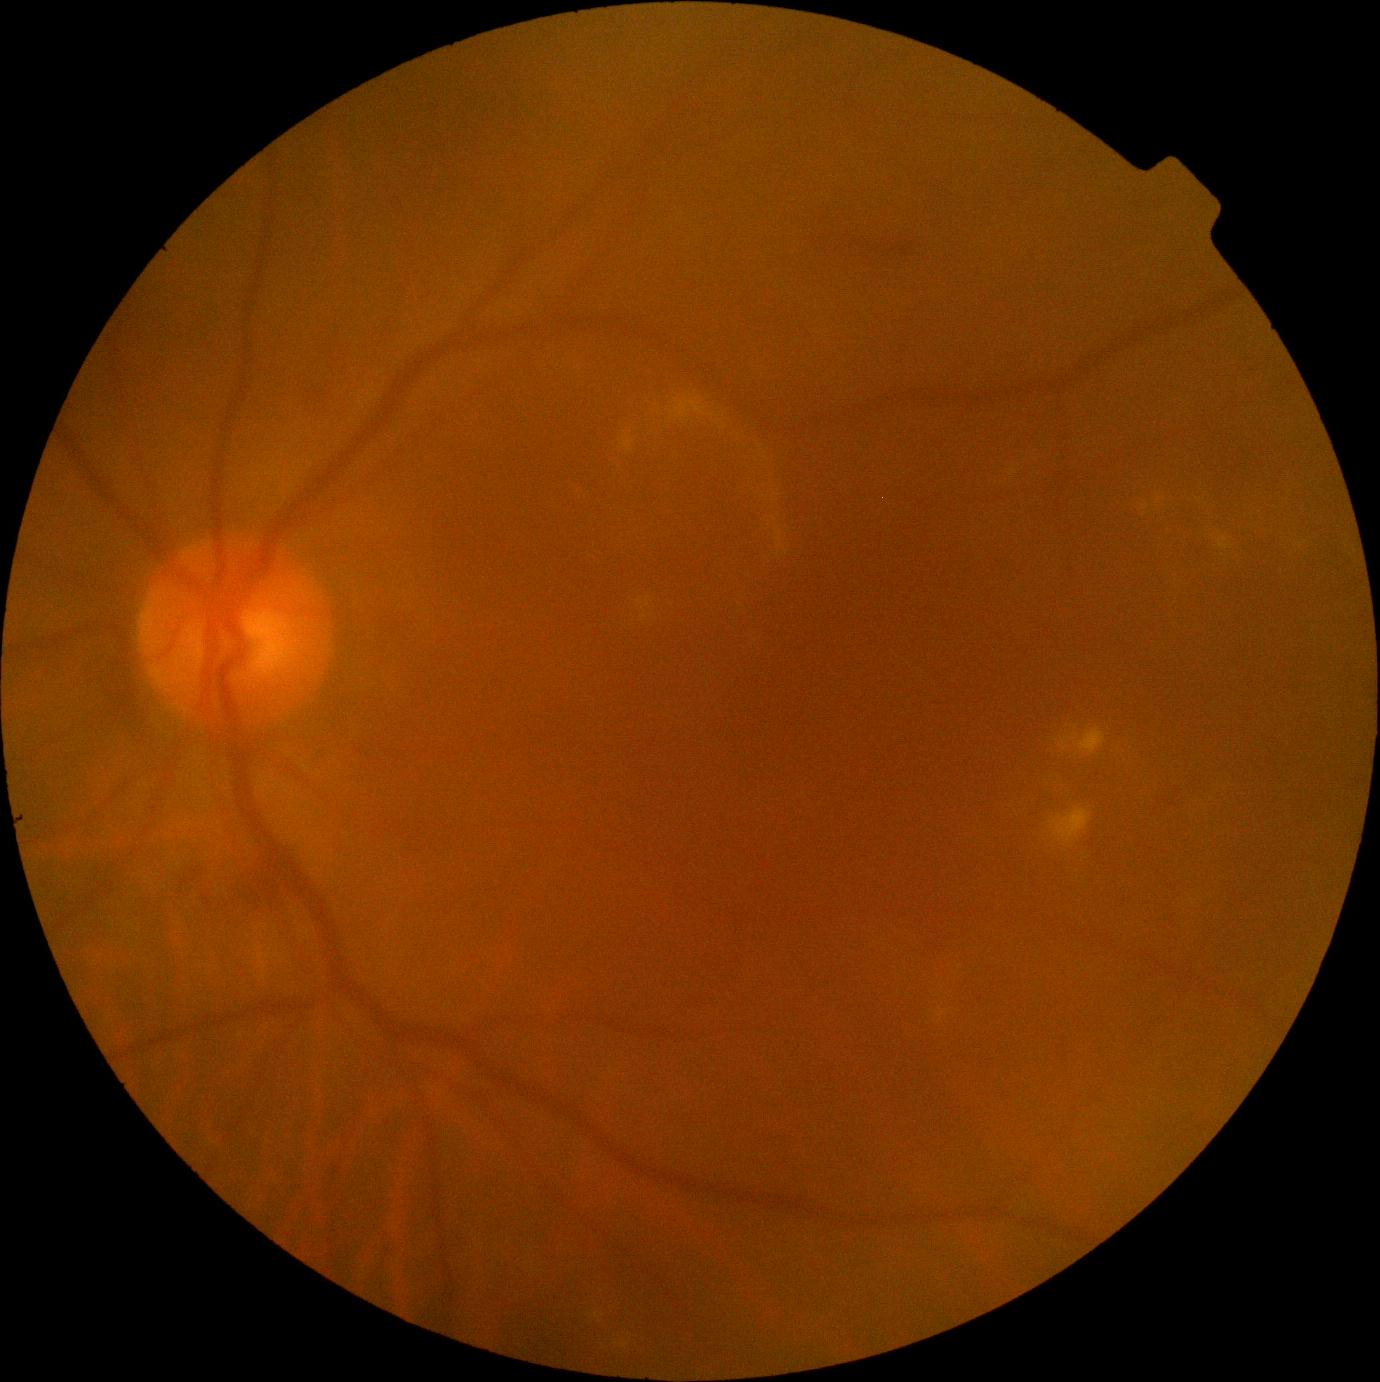

Diabetic retinopathy (DR): moderate non-proliferative diabetic retinopathy (grade 2); non-proliferative diabetic retinopathy
Lesions identified (partial list):
- hard exudates (EXs) (continued): Rect(1074, 727, 1107, 757), Rect(579, 546, 599, 563), Rect(1050, 808, 1092, 846), Rect(629, 387, 797, 551), Rect(1058, 727, 1080, 752), Rect(1218, 536, 1235, 550), Rect(1140, 503, 1150, 511), Rect(926, 1002, 964, 1040), Rect(575, 478, 604, 500)
- Additional small EXs near pt(1159, 500), pt(1301, 546)
- soft exudates (SEs): absent
- hemorrhages (HEs) (continued): Rect(274, 869, 285, 877), Rect(241, 869, 277, 904), Rect(833, 229, 913, 258), Rect(172, 859, 200, 898), Rect(511, 1308, 608, 1360)
- Additional small HEs near pt(1173, 805), pt(271, 871)
- microaneurysms (MAs): Rect(352, 746, 365, 761), Rect(204, 898, 212, 907)